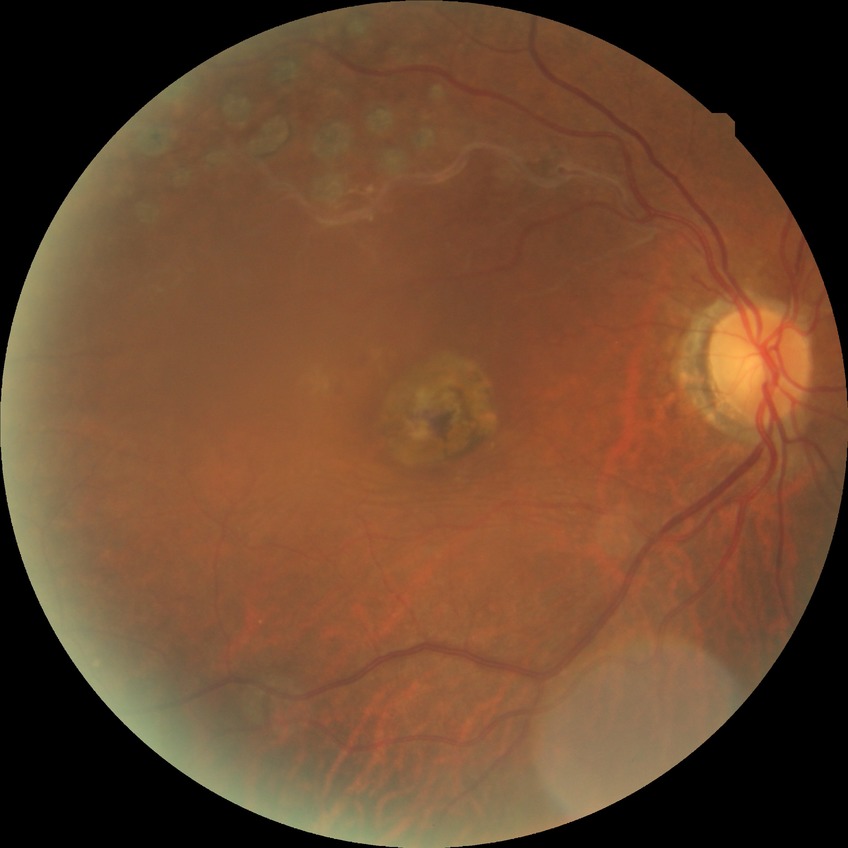

diabetic retinopathy (DR)@no diabetic retinopathy (NDR).